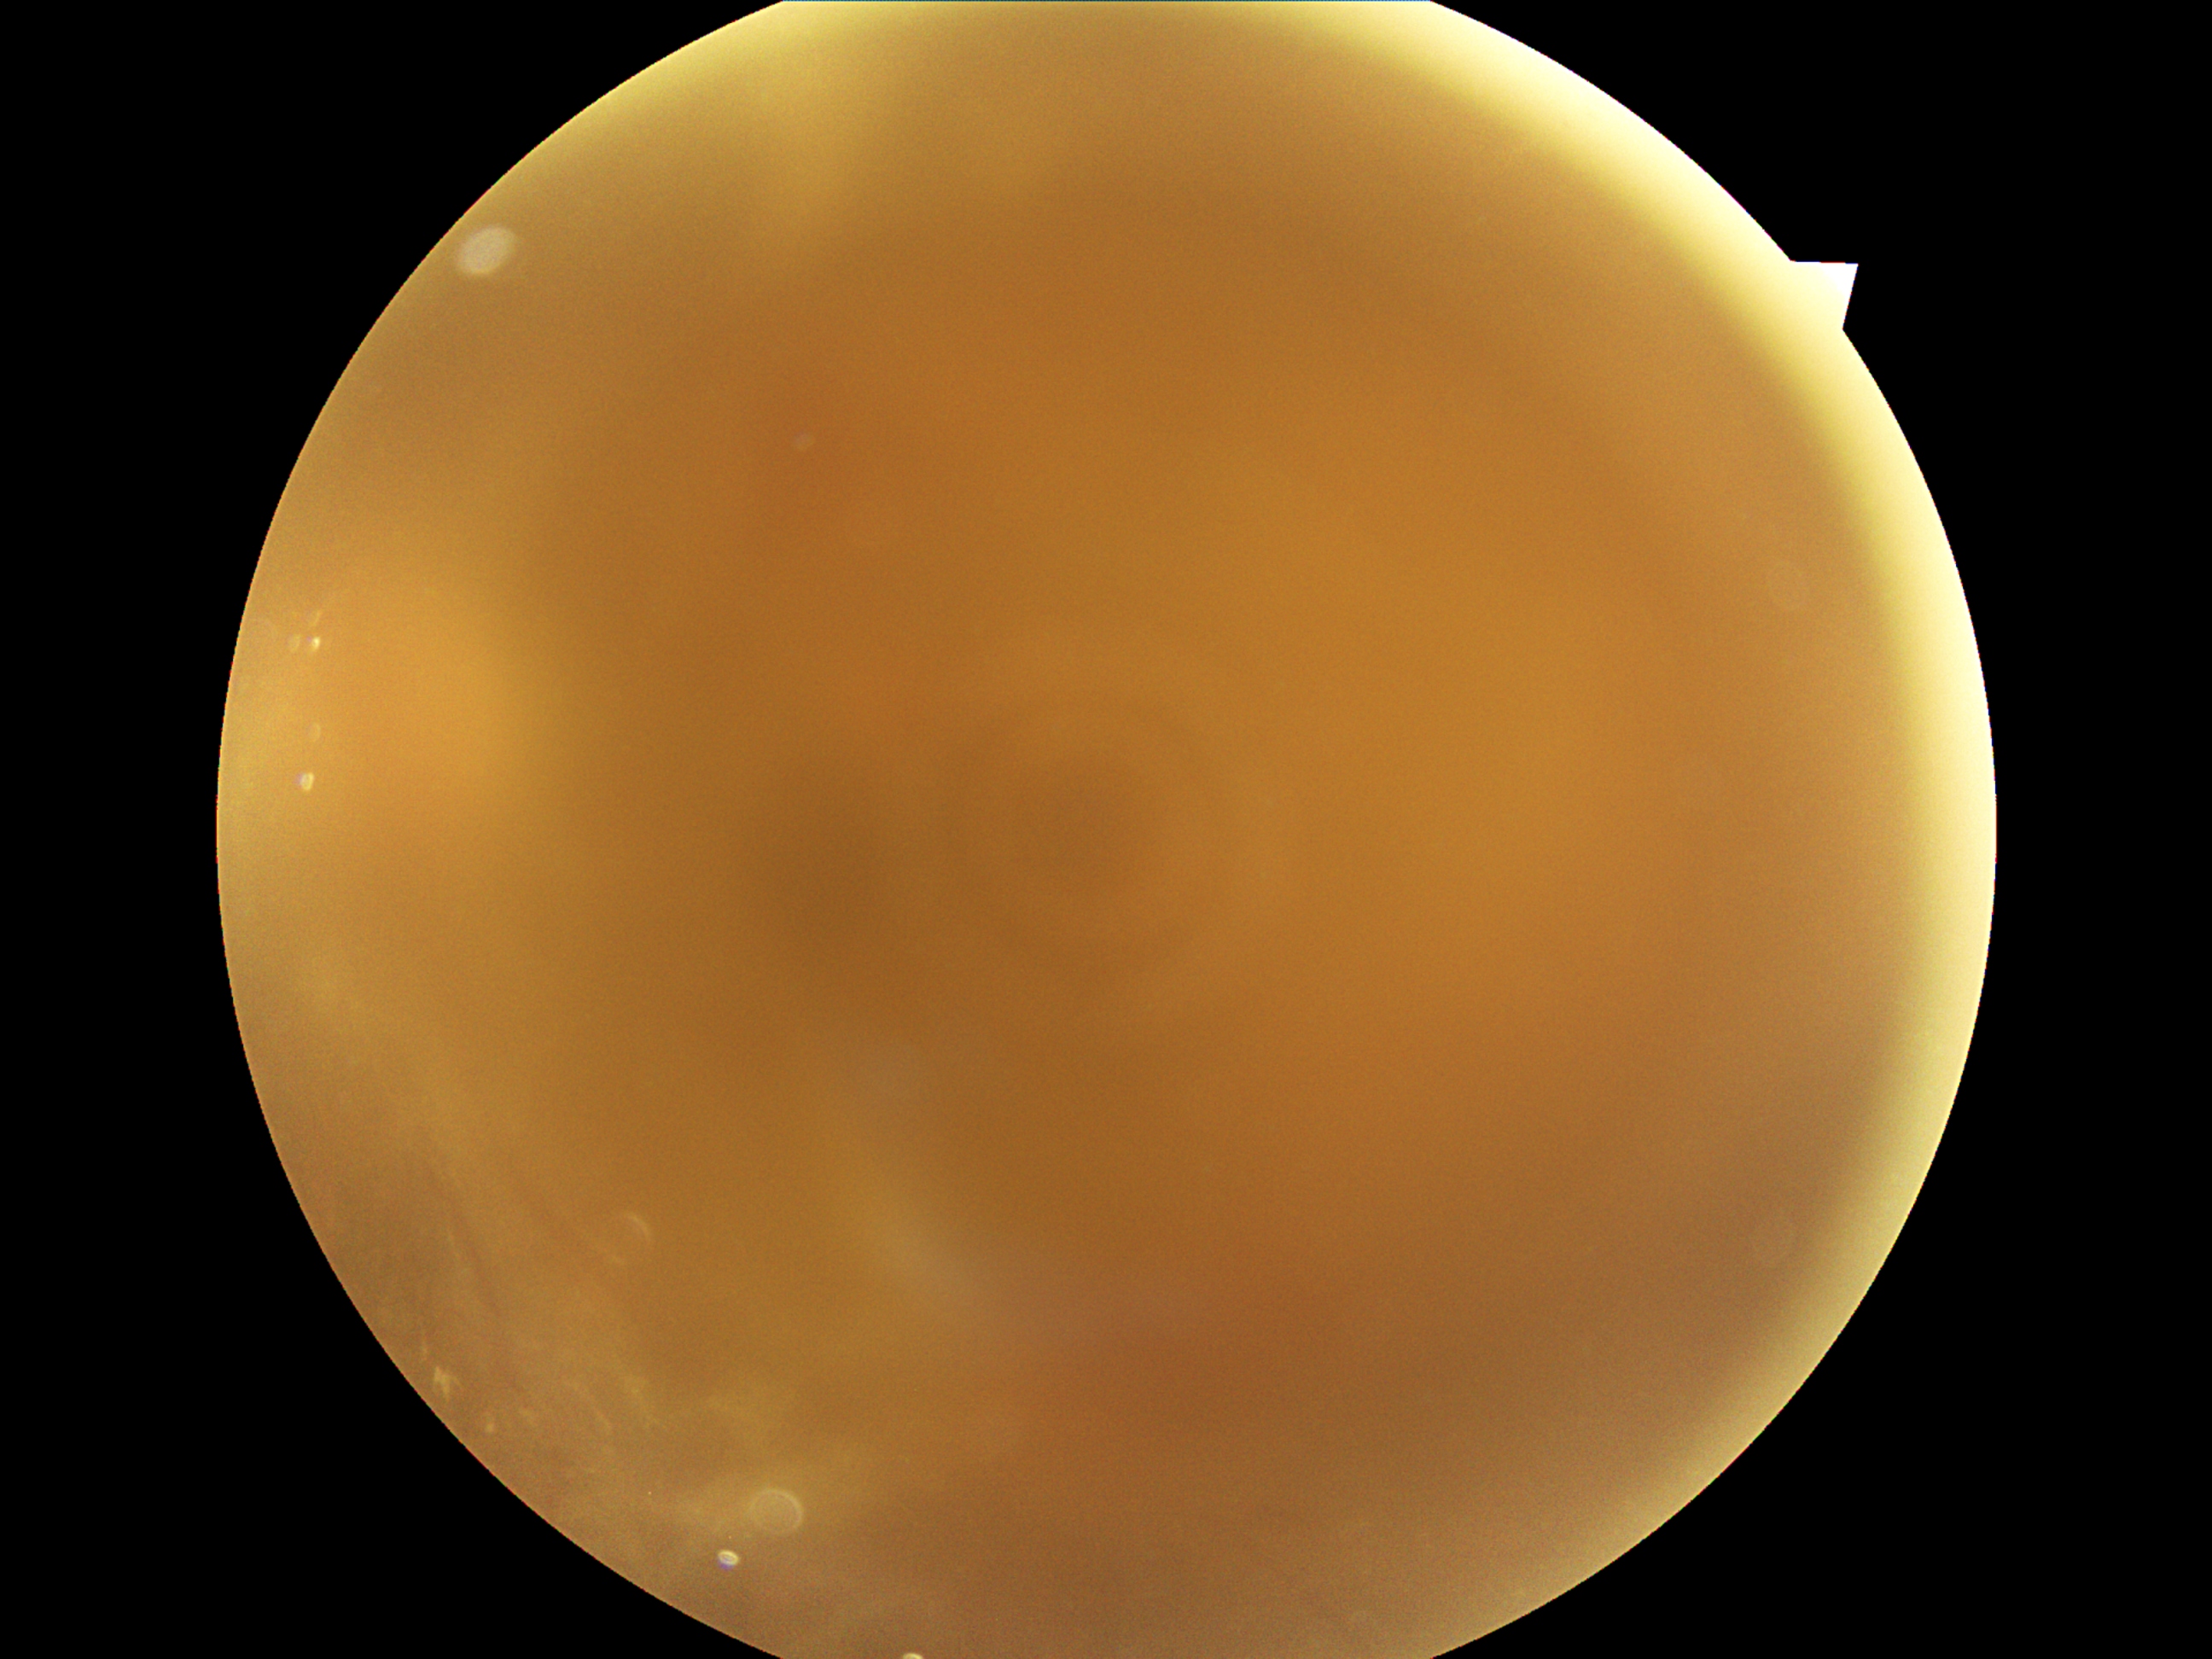 retinopathy@ungradable due to poor image quality, image quality@insufficient.